Retinal fundus photograph
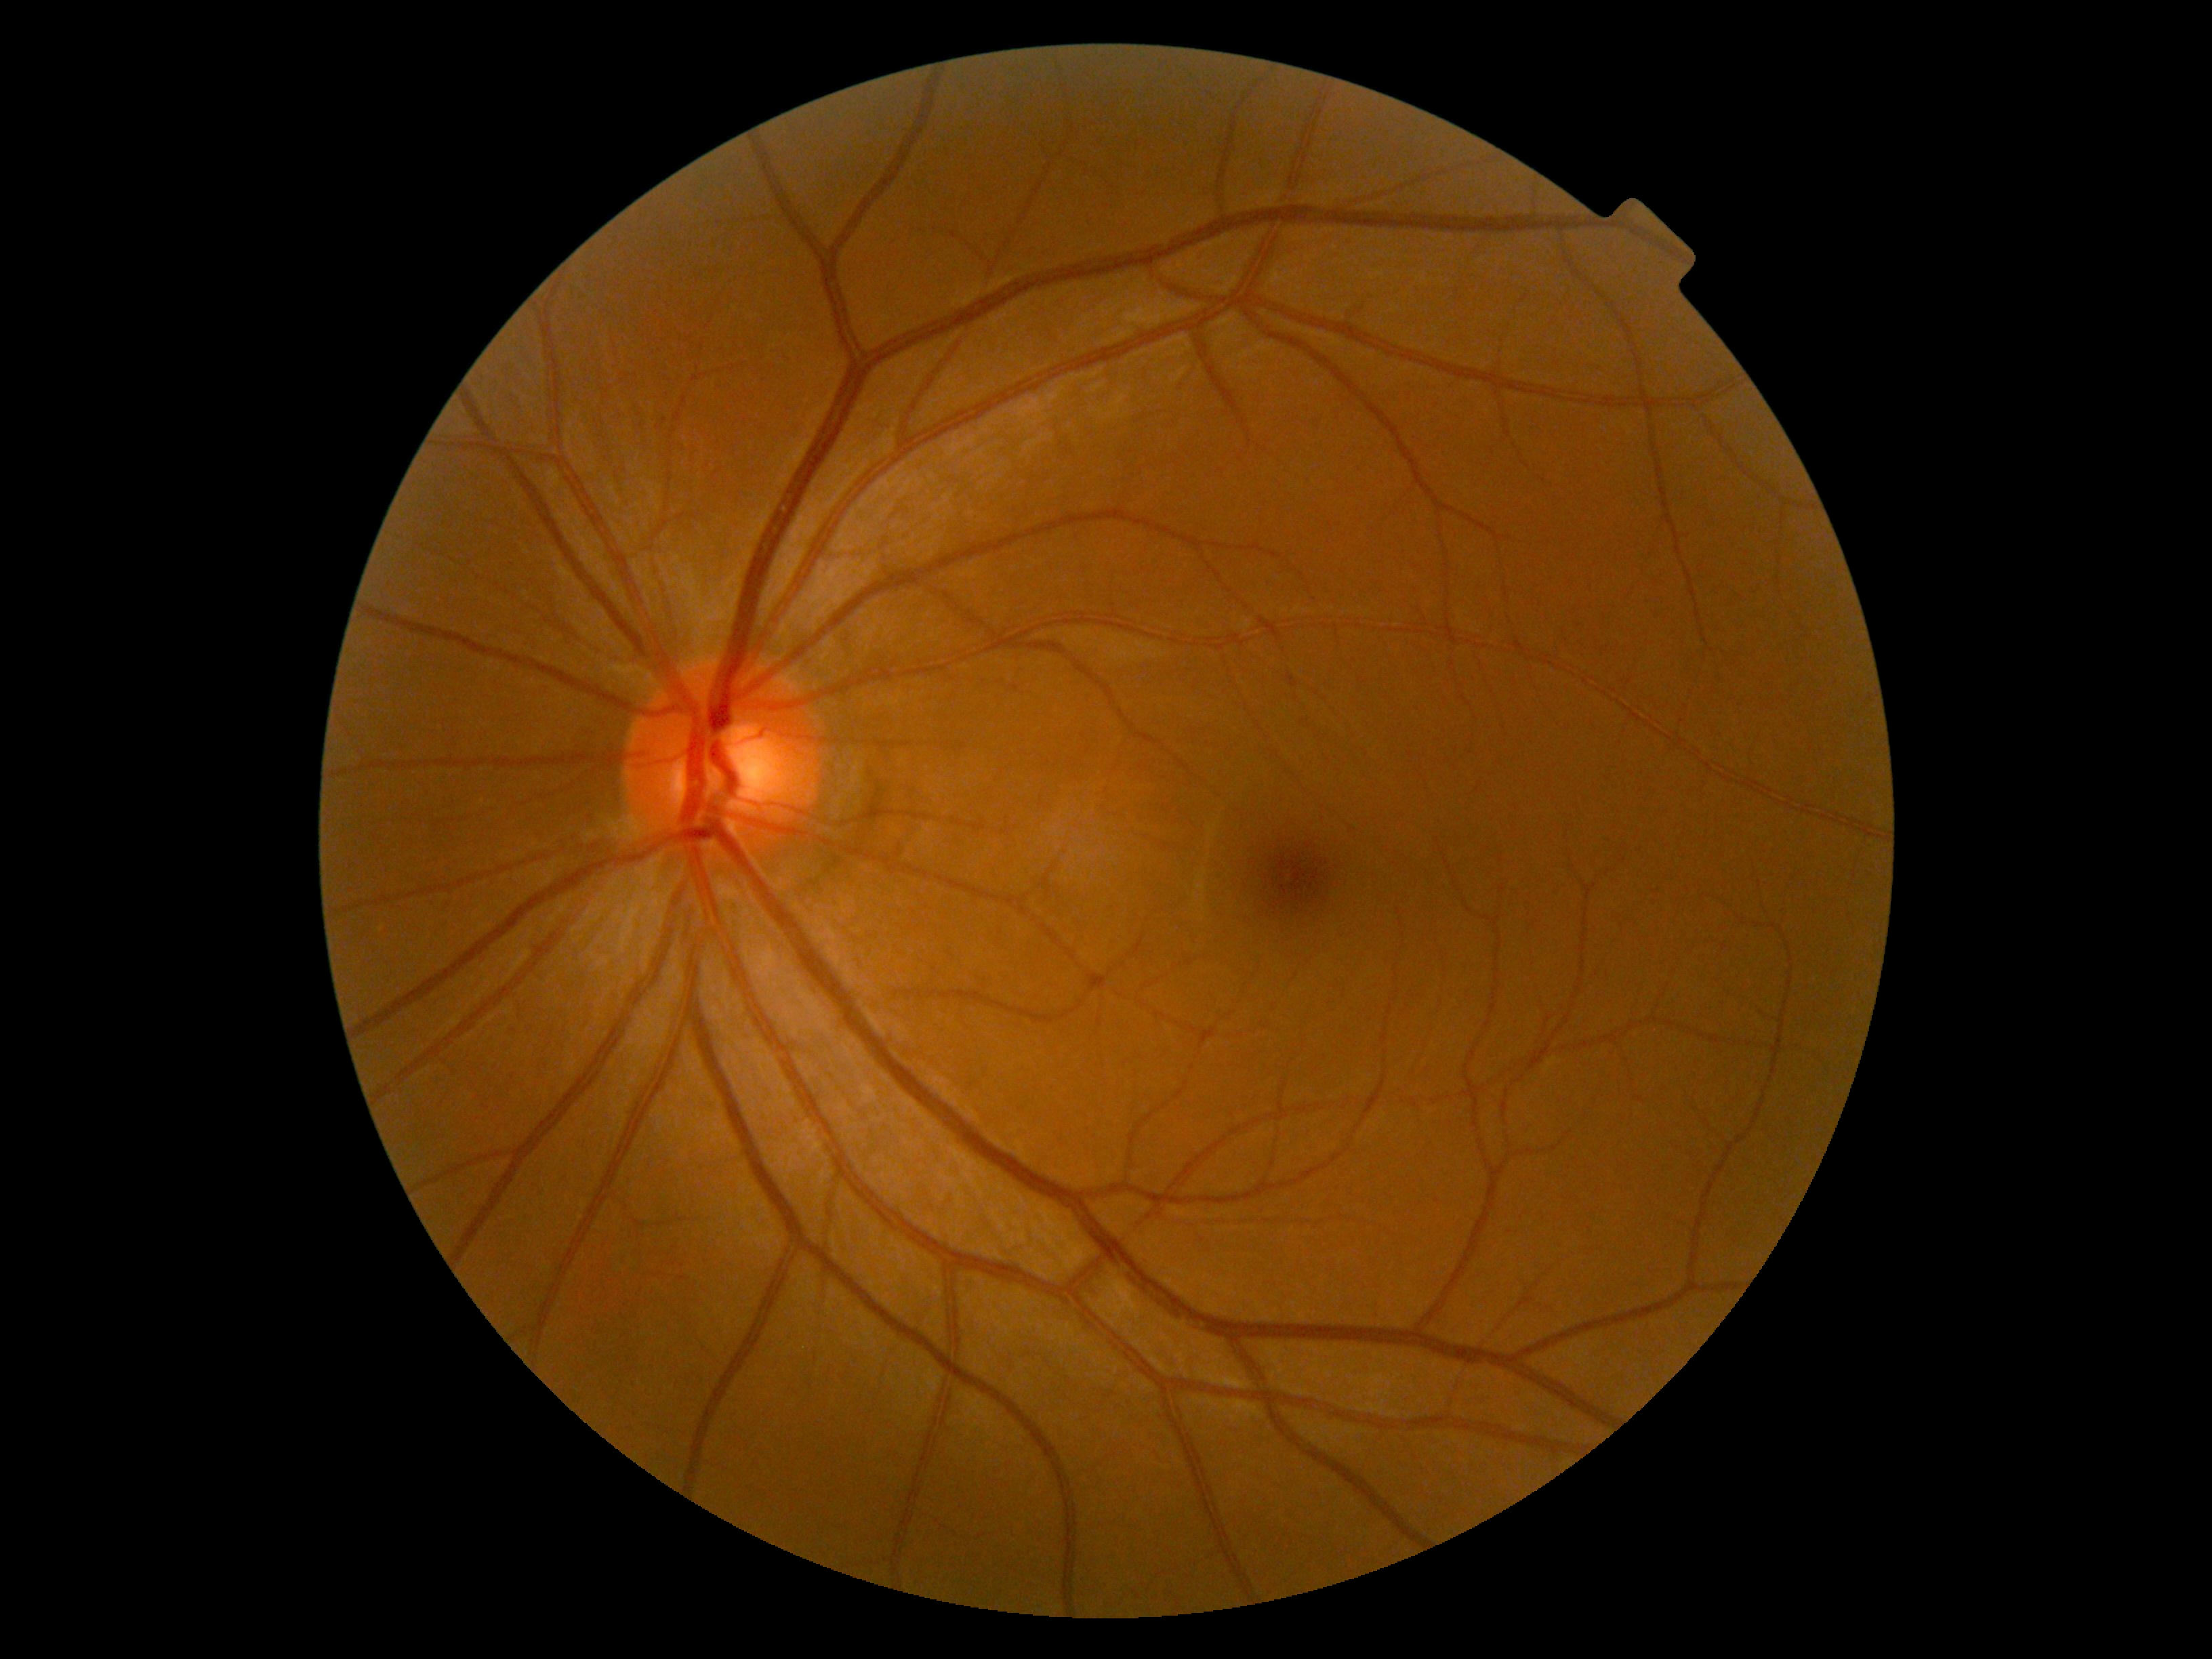
DR impression: negative for DR; diabetic retinopathy: grade 0 (no apparent retinopathy) — no visible signs of diabetic retinopathy.